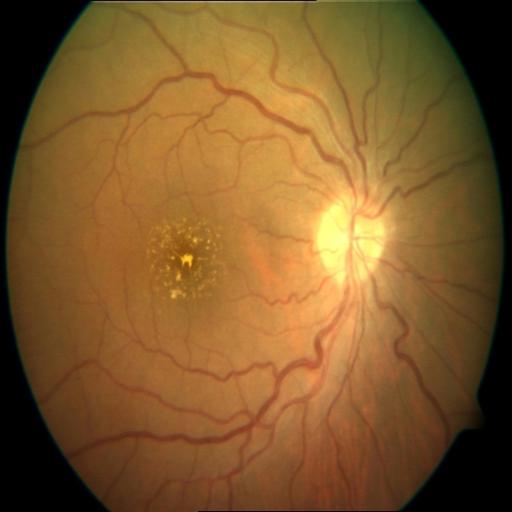

Diagnoses: drusen.